Optic nerve head crop:
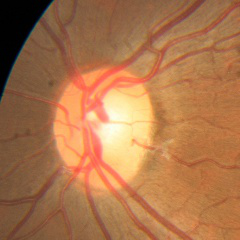

Glaucoma stage = no evidence of glaucoma.